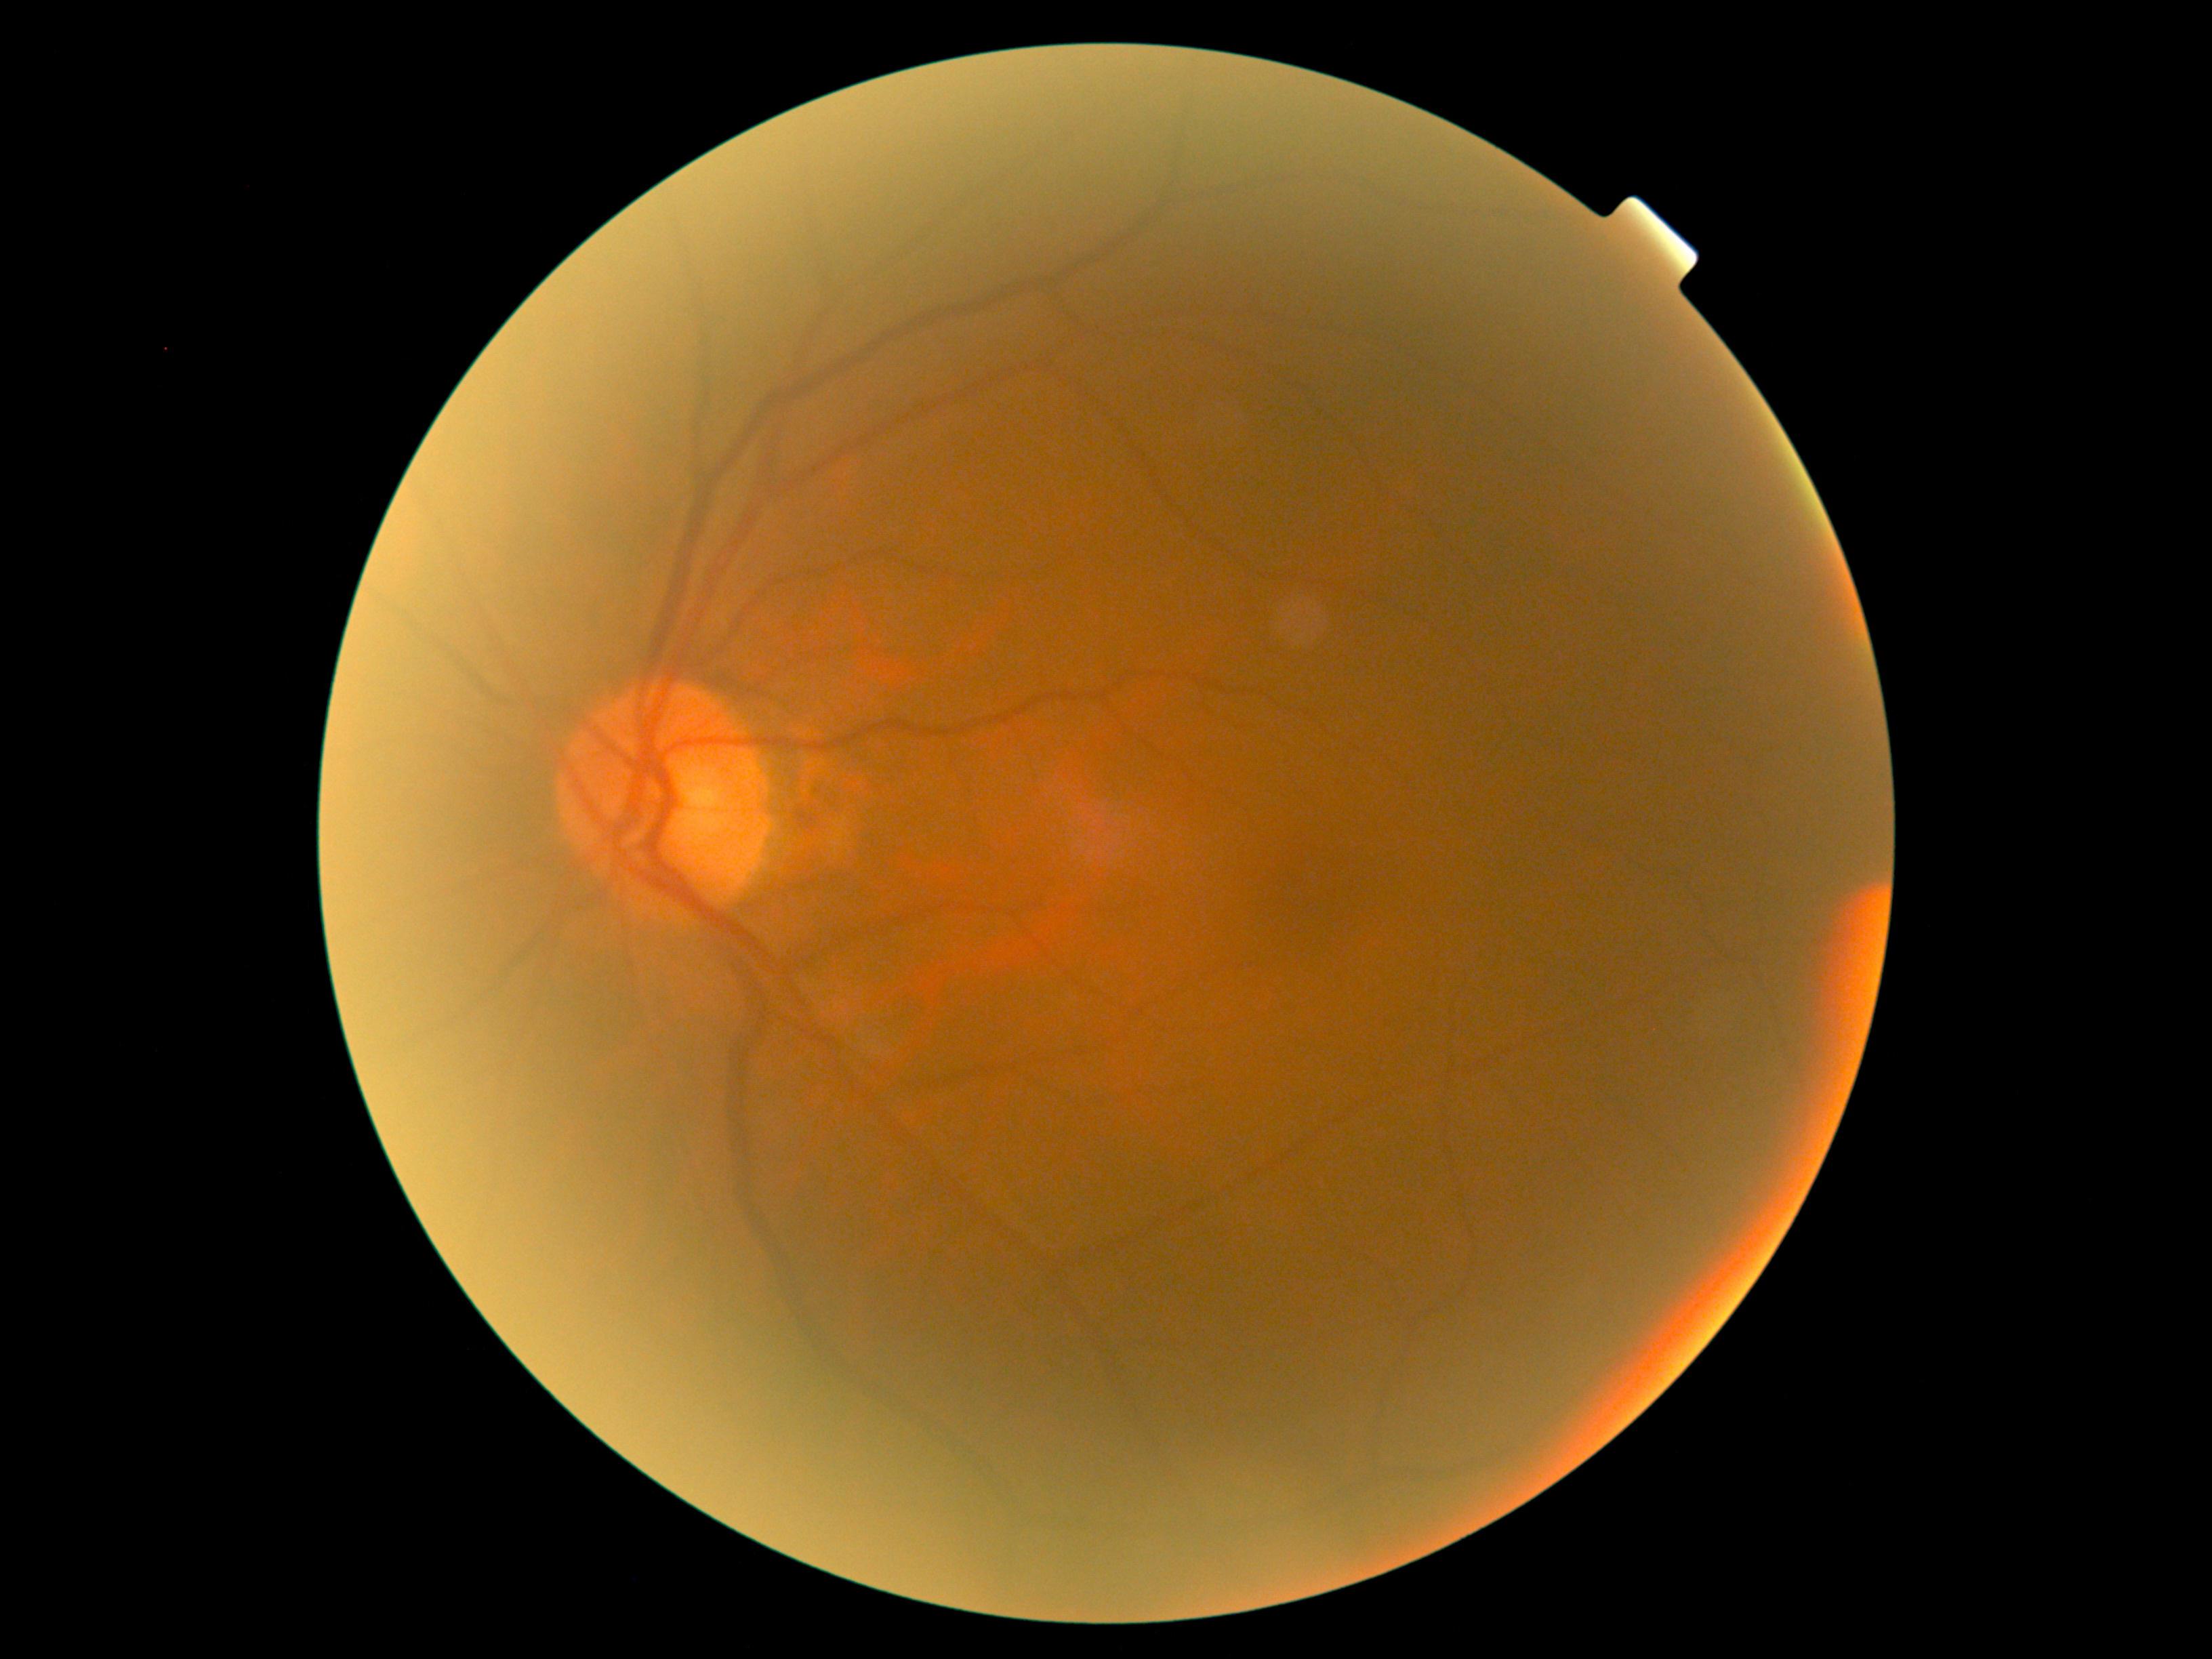
Retinopathy is grade 0 (no apparent retinopathy).